Wide-field fundus photograph of an infant
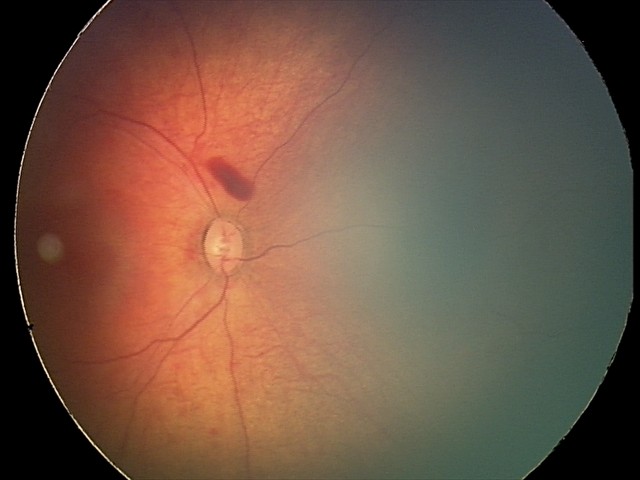
Assessment: retinal hemorrhages.